CFP, camera: Bosch fundus camera:
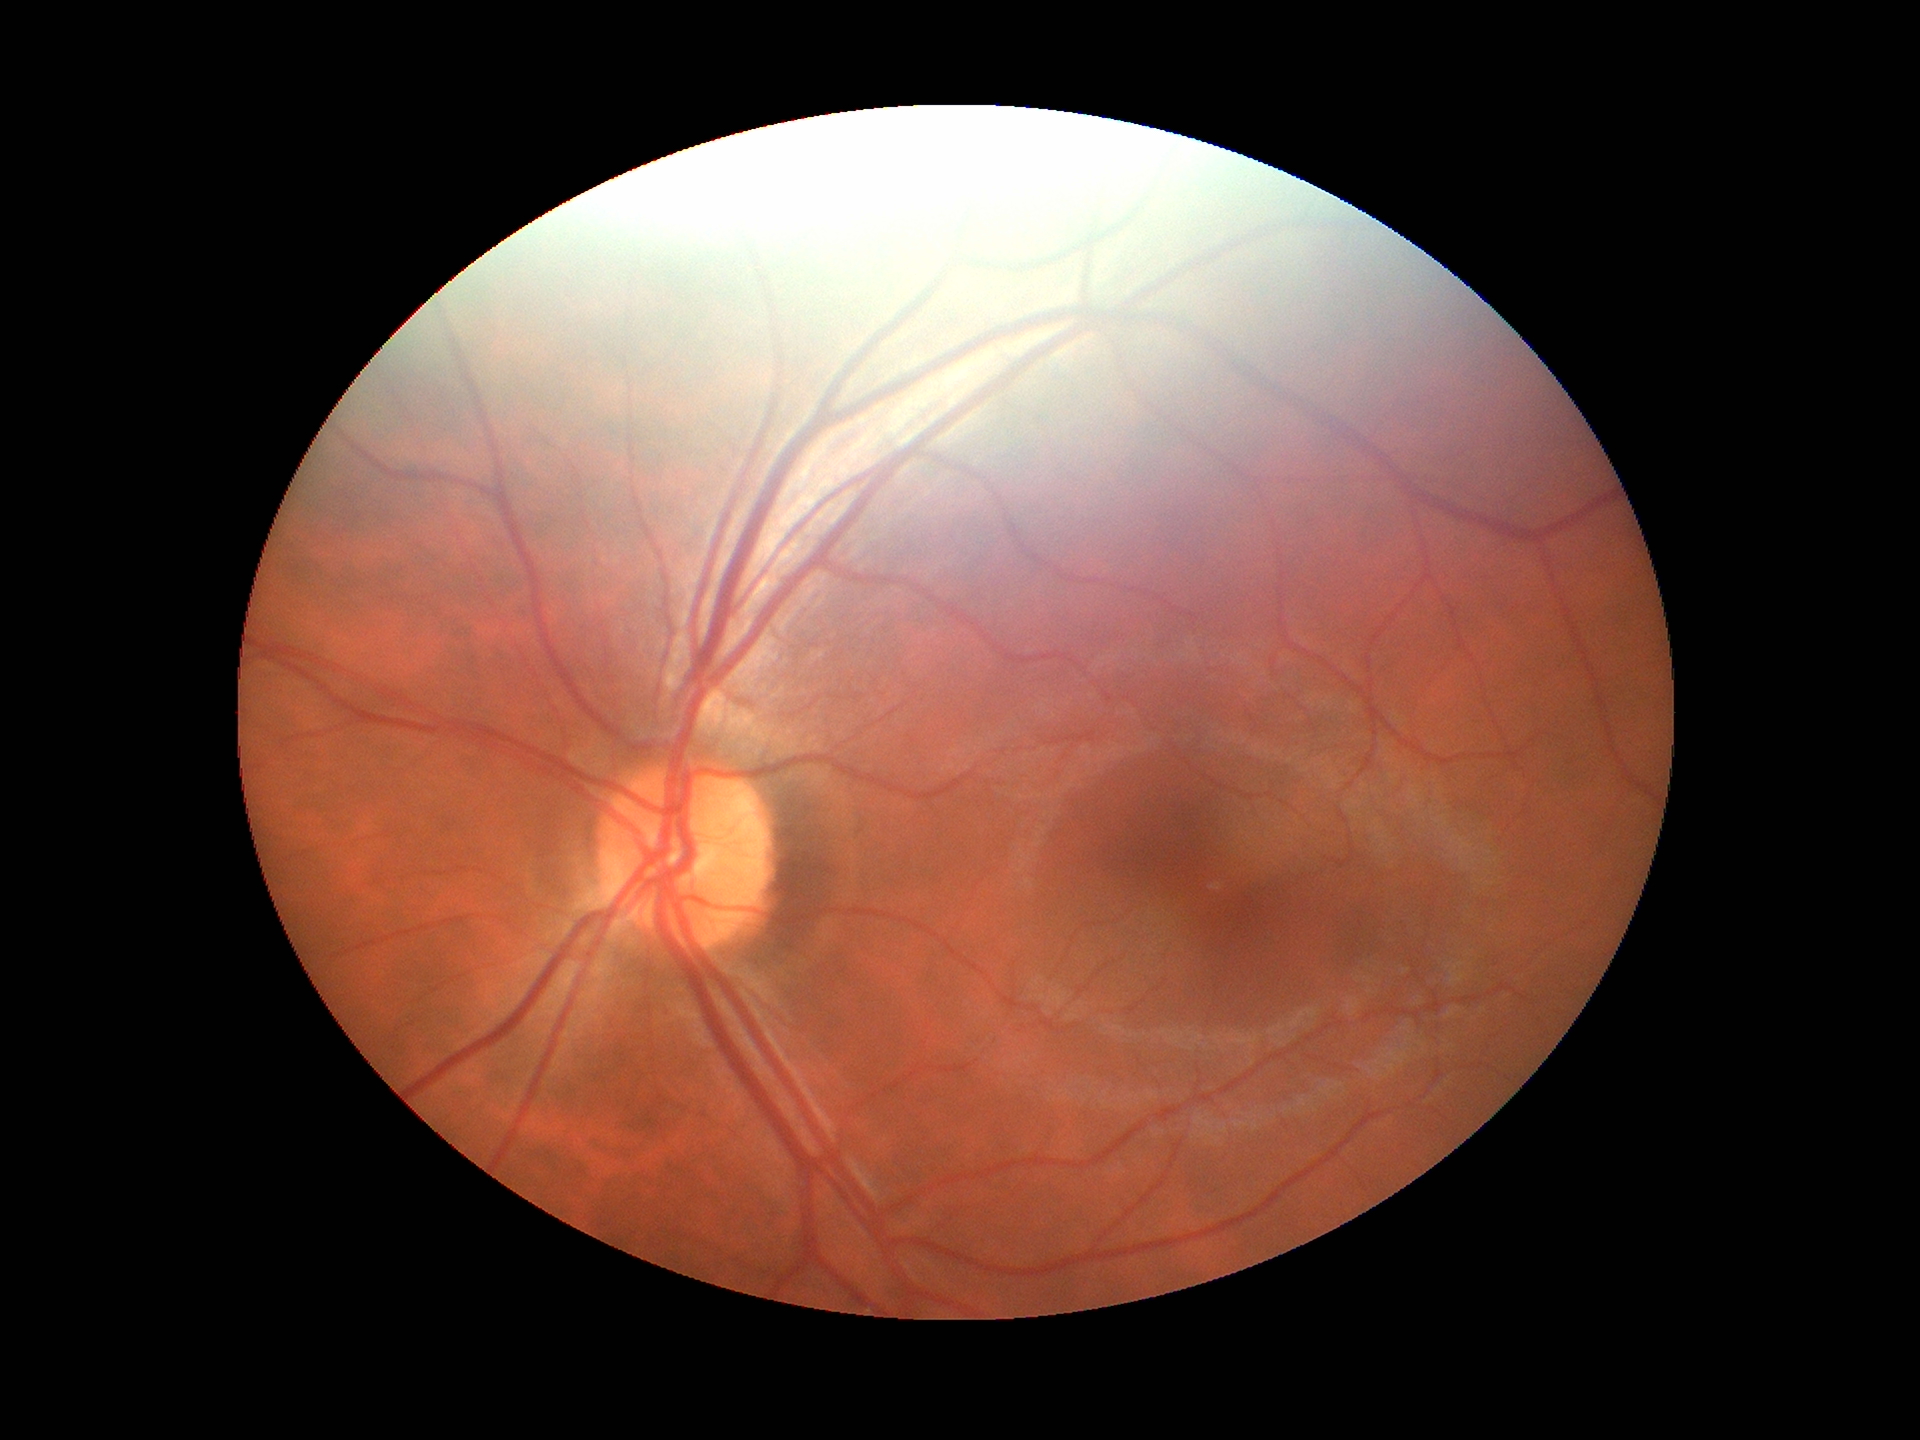 Glaucoma decision: not suspect. Vertical C/D ratio of 0.49. Horizontal C/D ratio of 0.48. Area cup-to-disc ratio: 0.23.